Image size 848x848 — 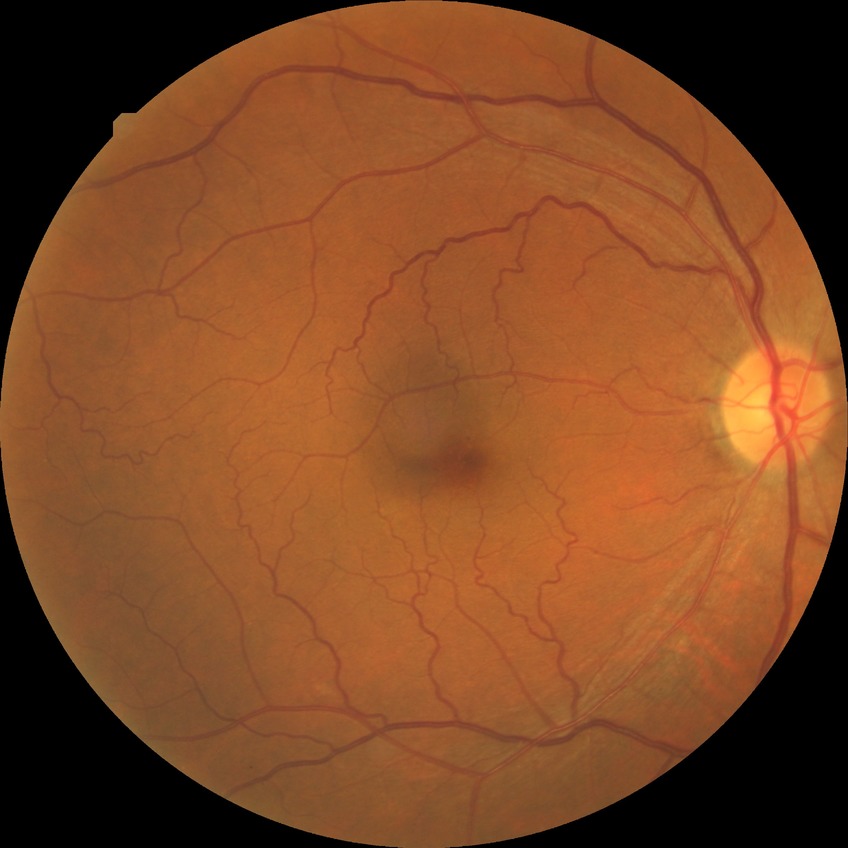
Findings:
– diabetic retinopathy stage: simple diabetic retinopathy